100° field of view (Phoenix ICON); wide-field fundus image from infant ROP screening; 1240 by 1240 pixels
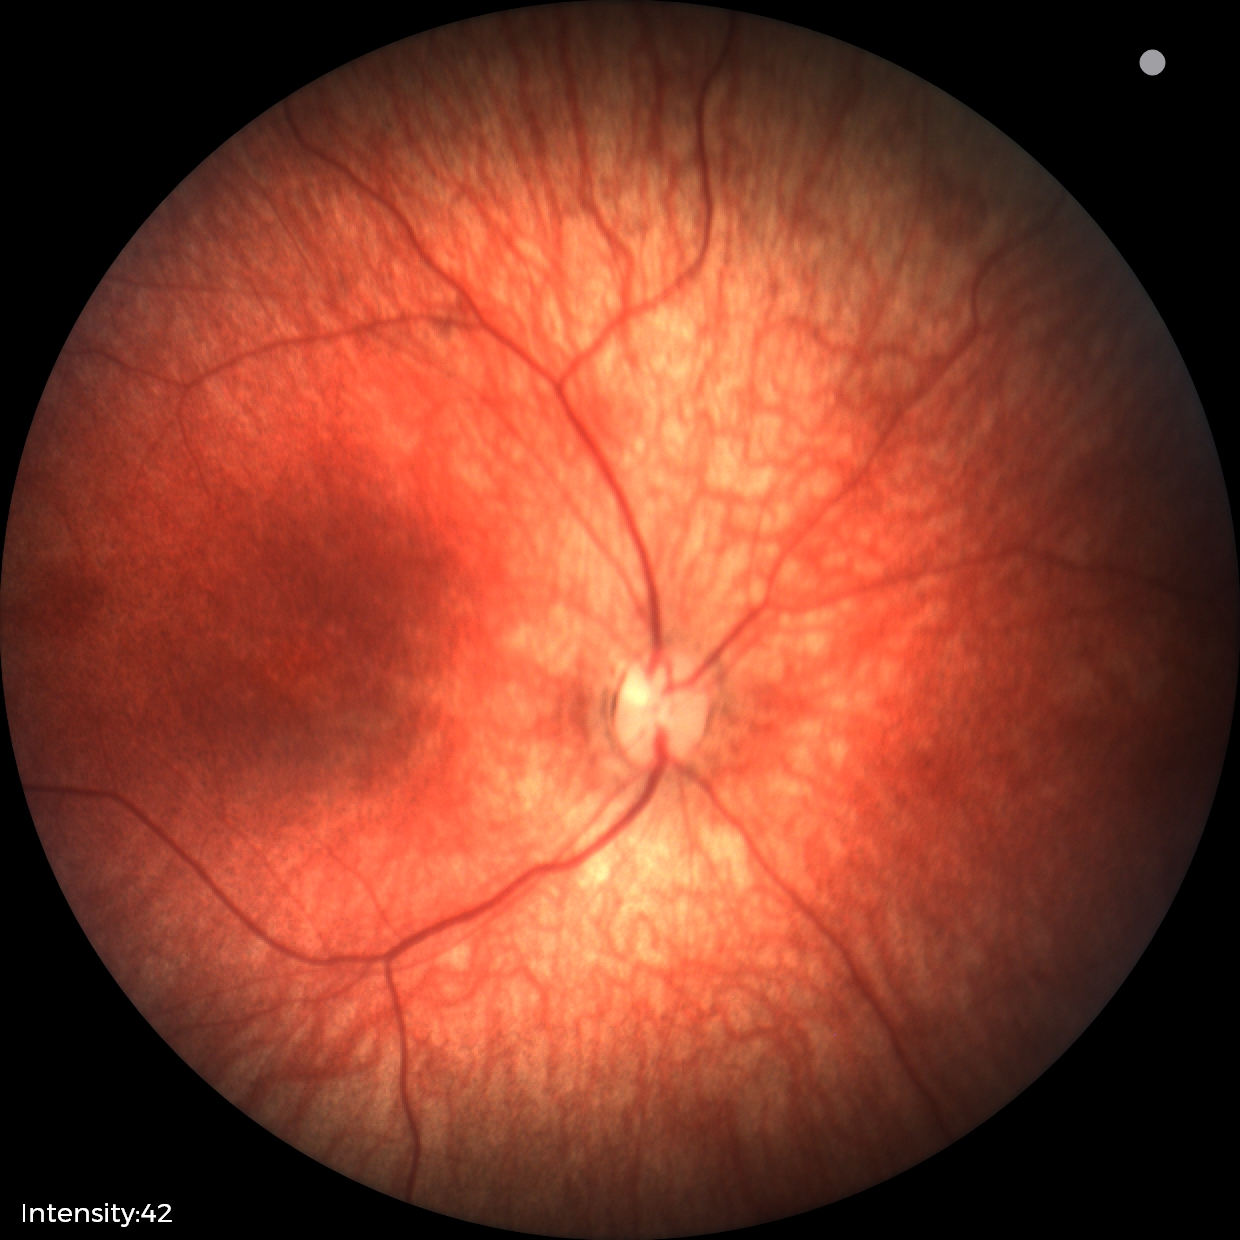
Impression: normal retinal appearance.